DR severity per modified Davis staging. 45° FOV. NIDEK AFC-230 fundus camera: 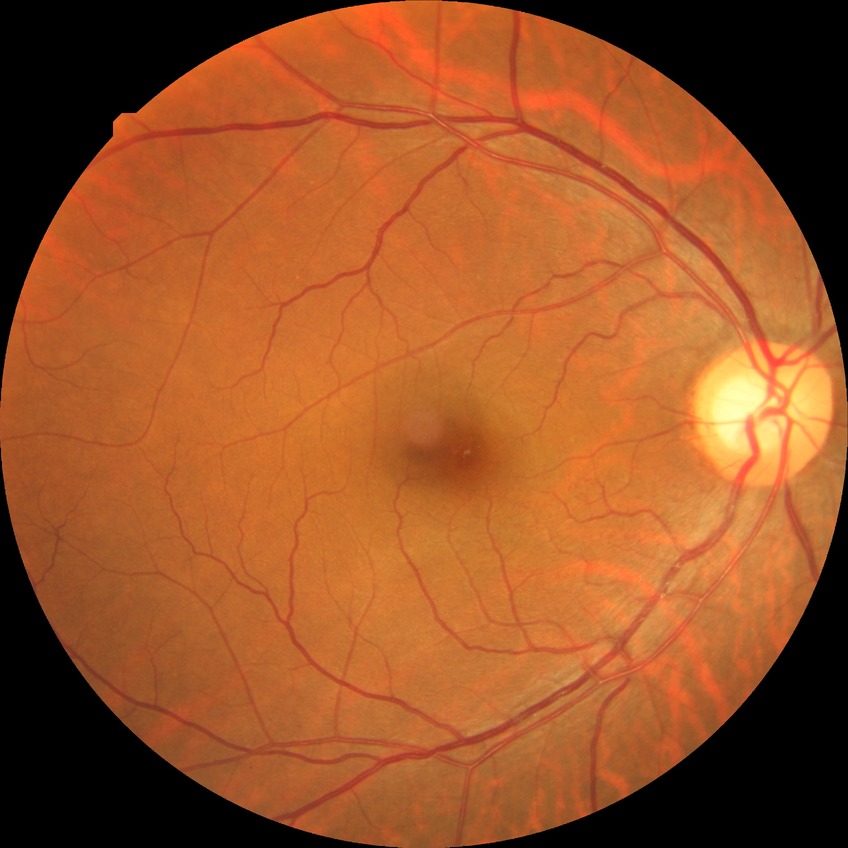
Diabetic retinopathy severity is no diabetic retinopathy.